2048 by 1536 pixels — 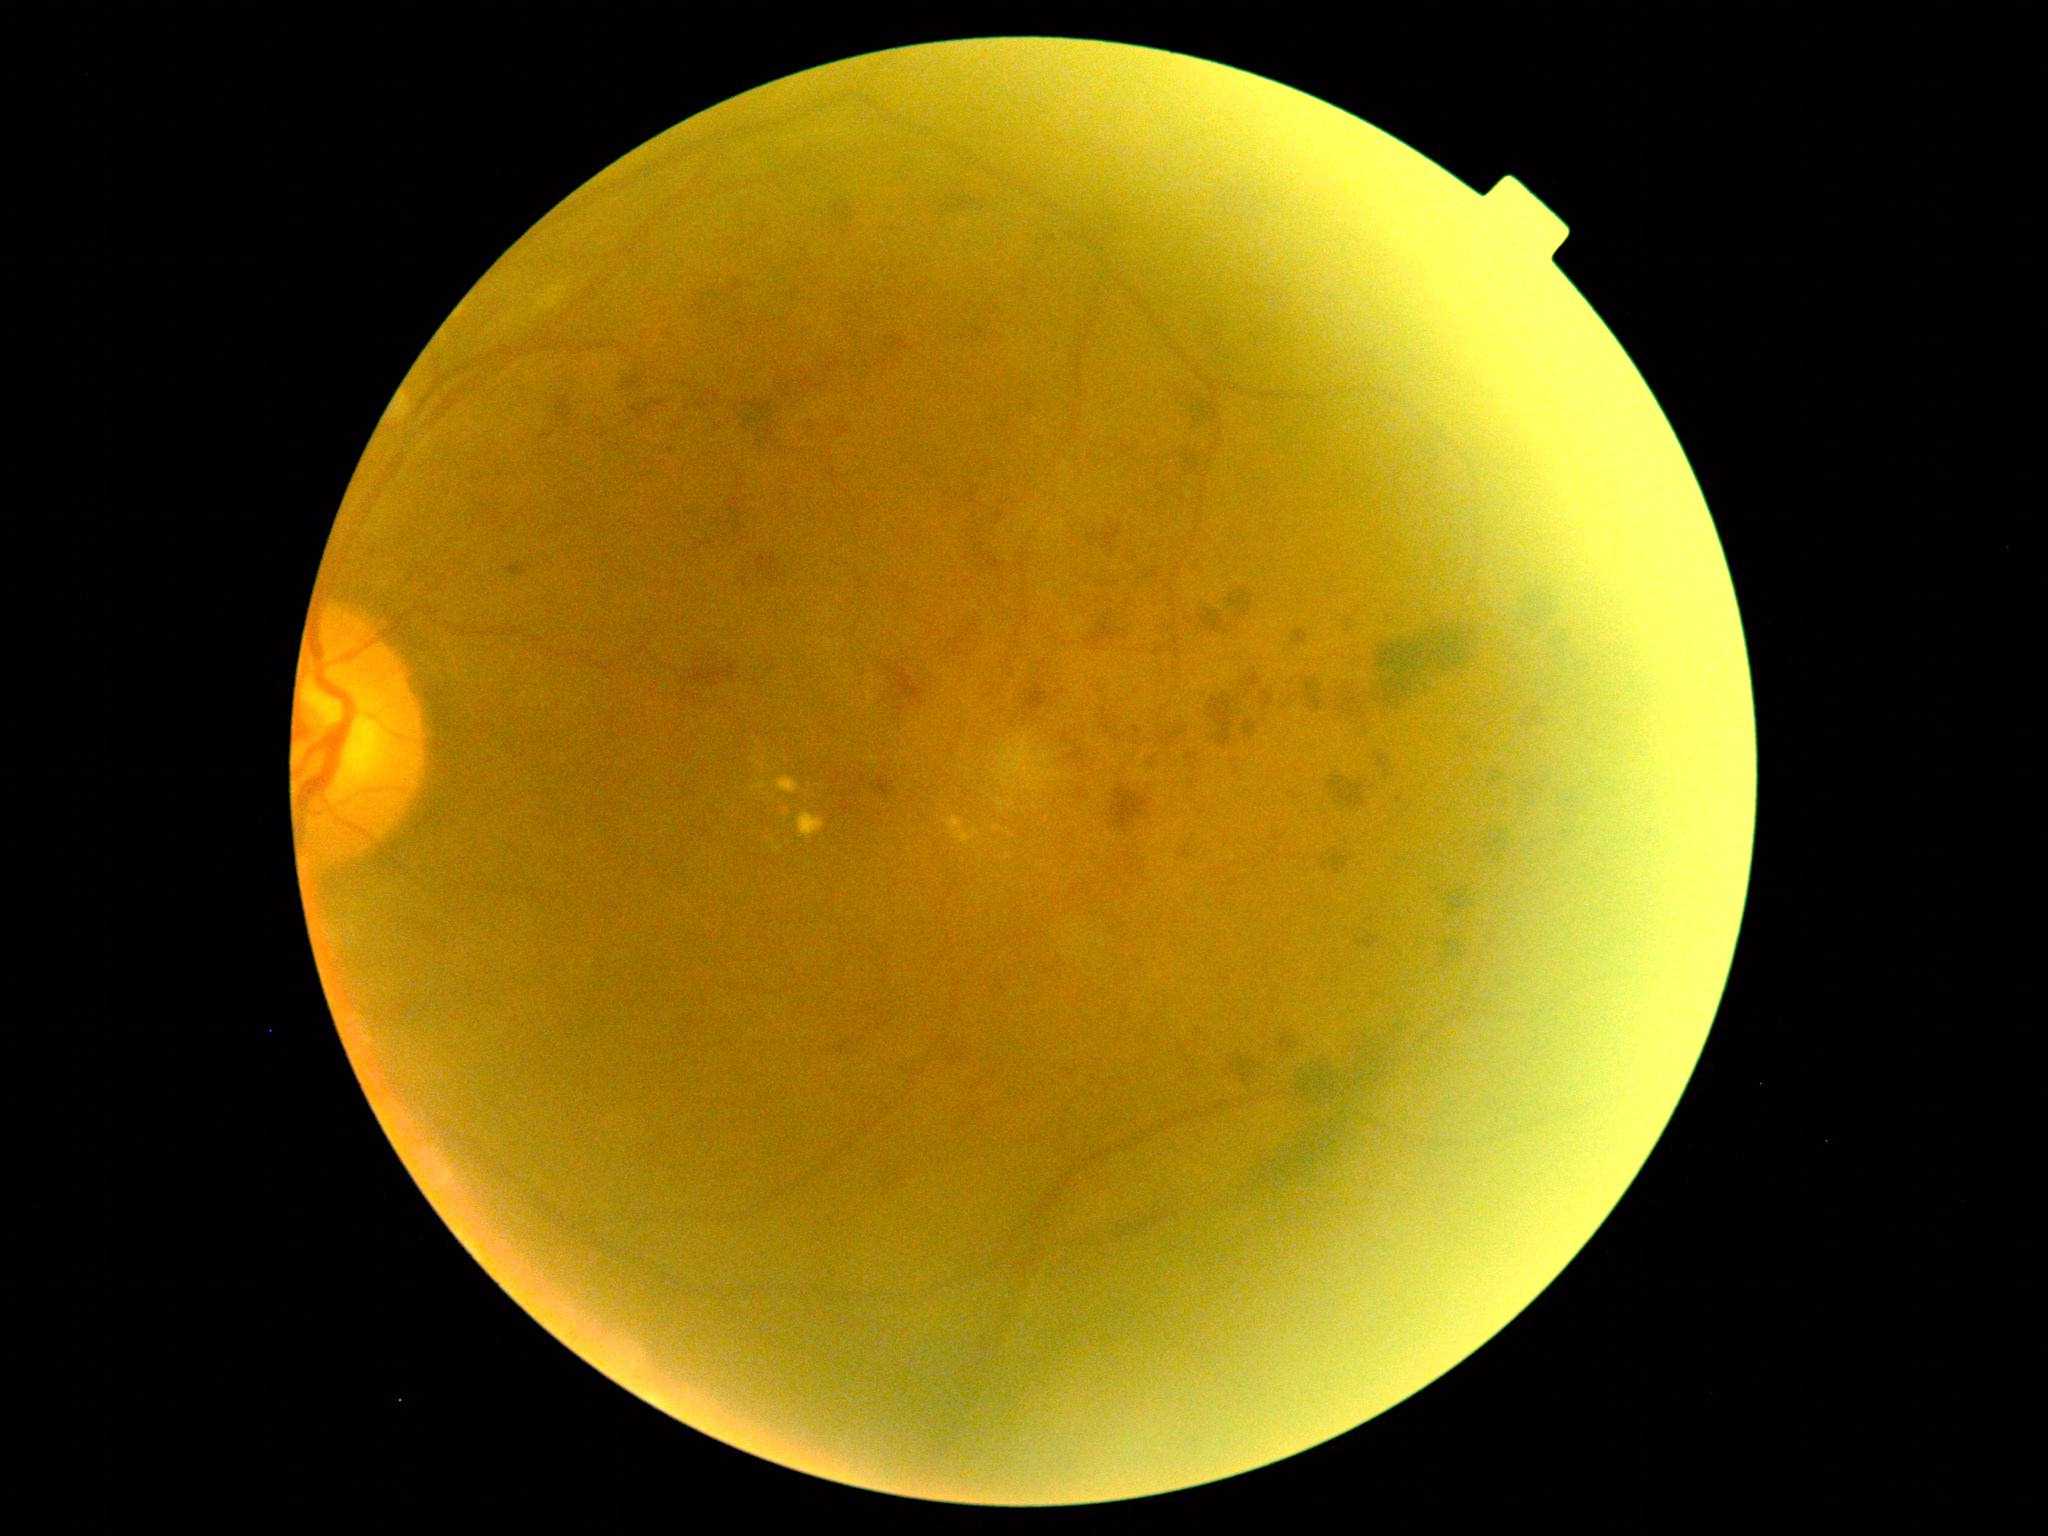 DR is grade 2 — more than just microaneurysms but less than severe NPDR. Disease class: non-proliferative diabetic retinopathy.